CFP; 2212x1659px; 45-degree field of view: 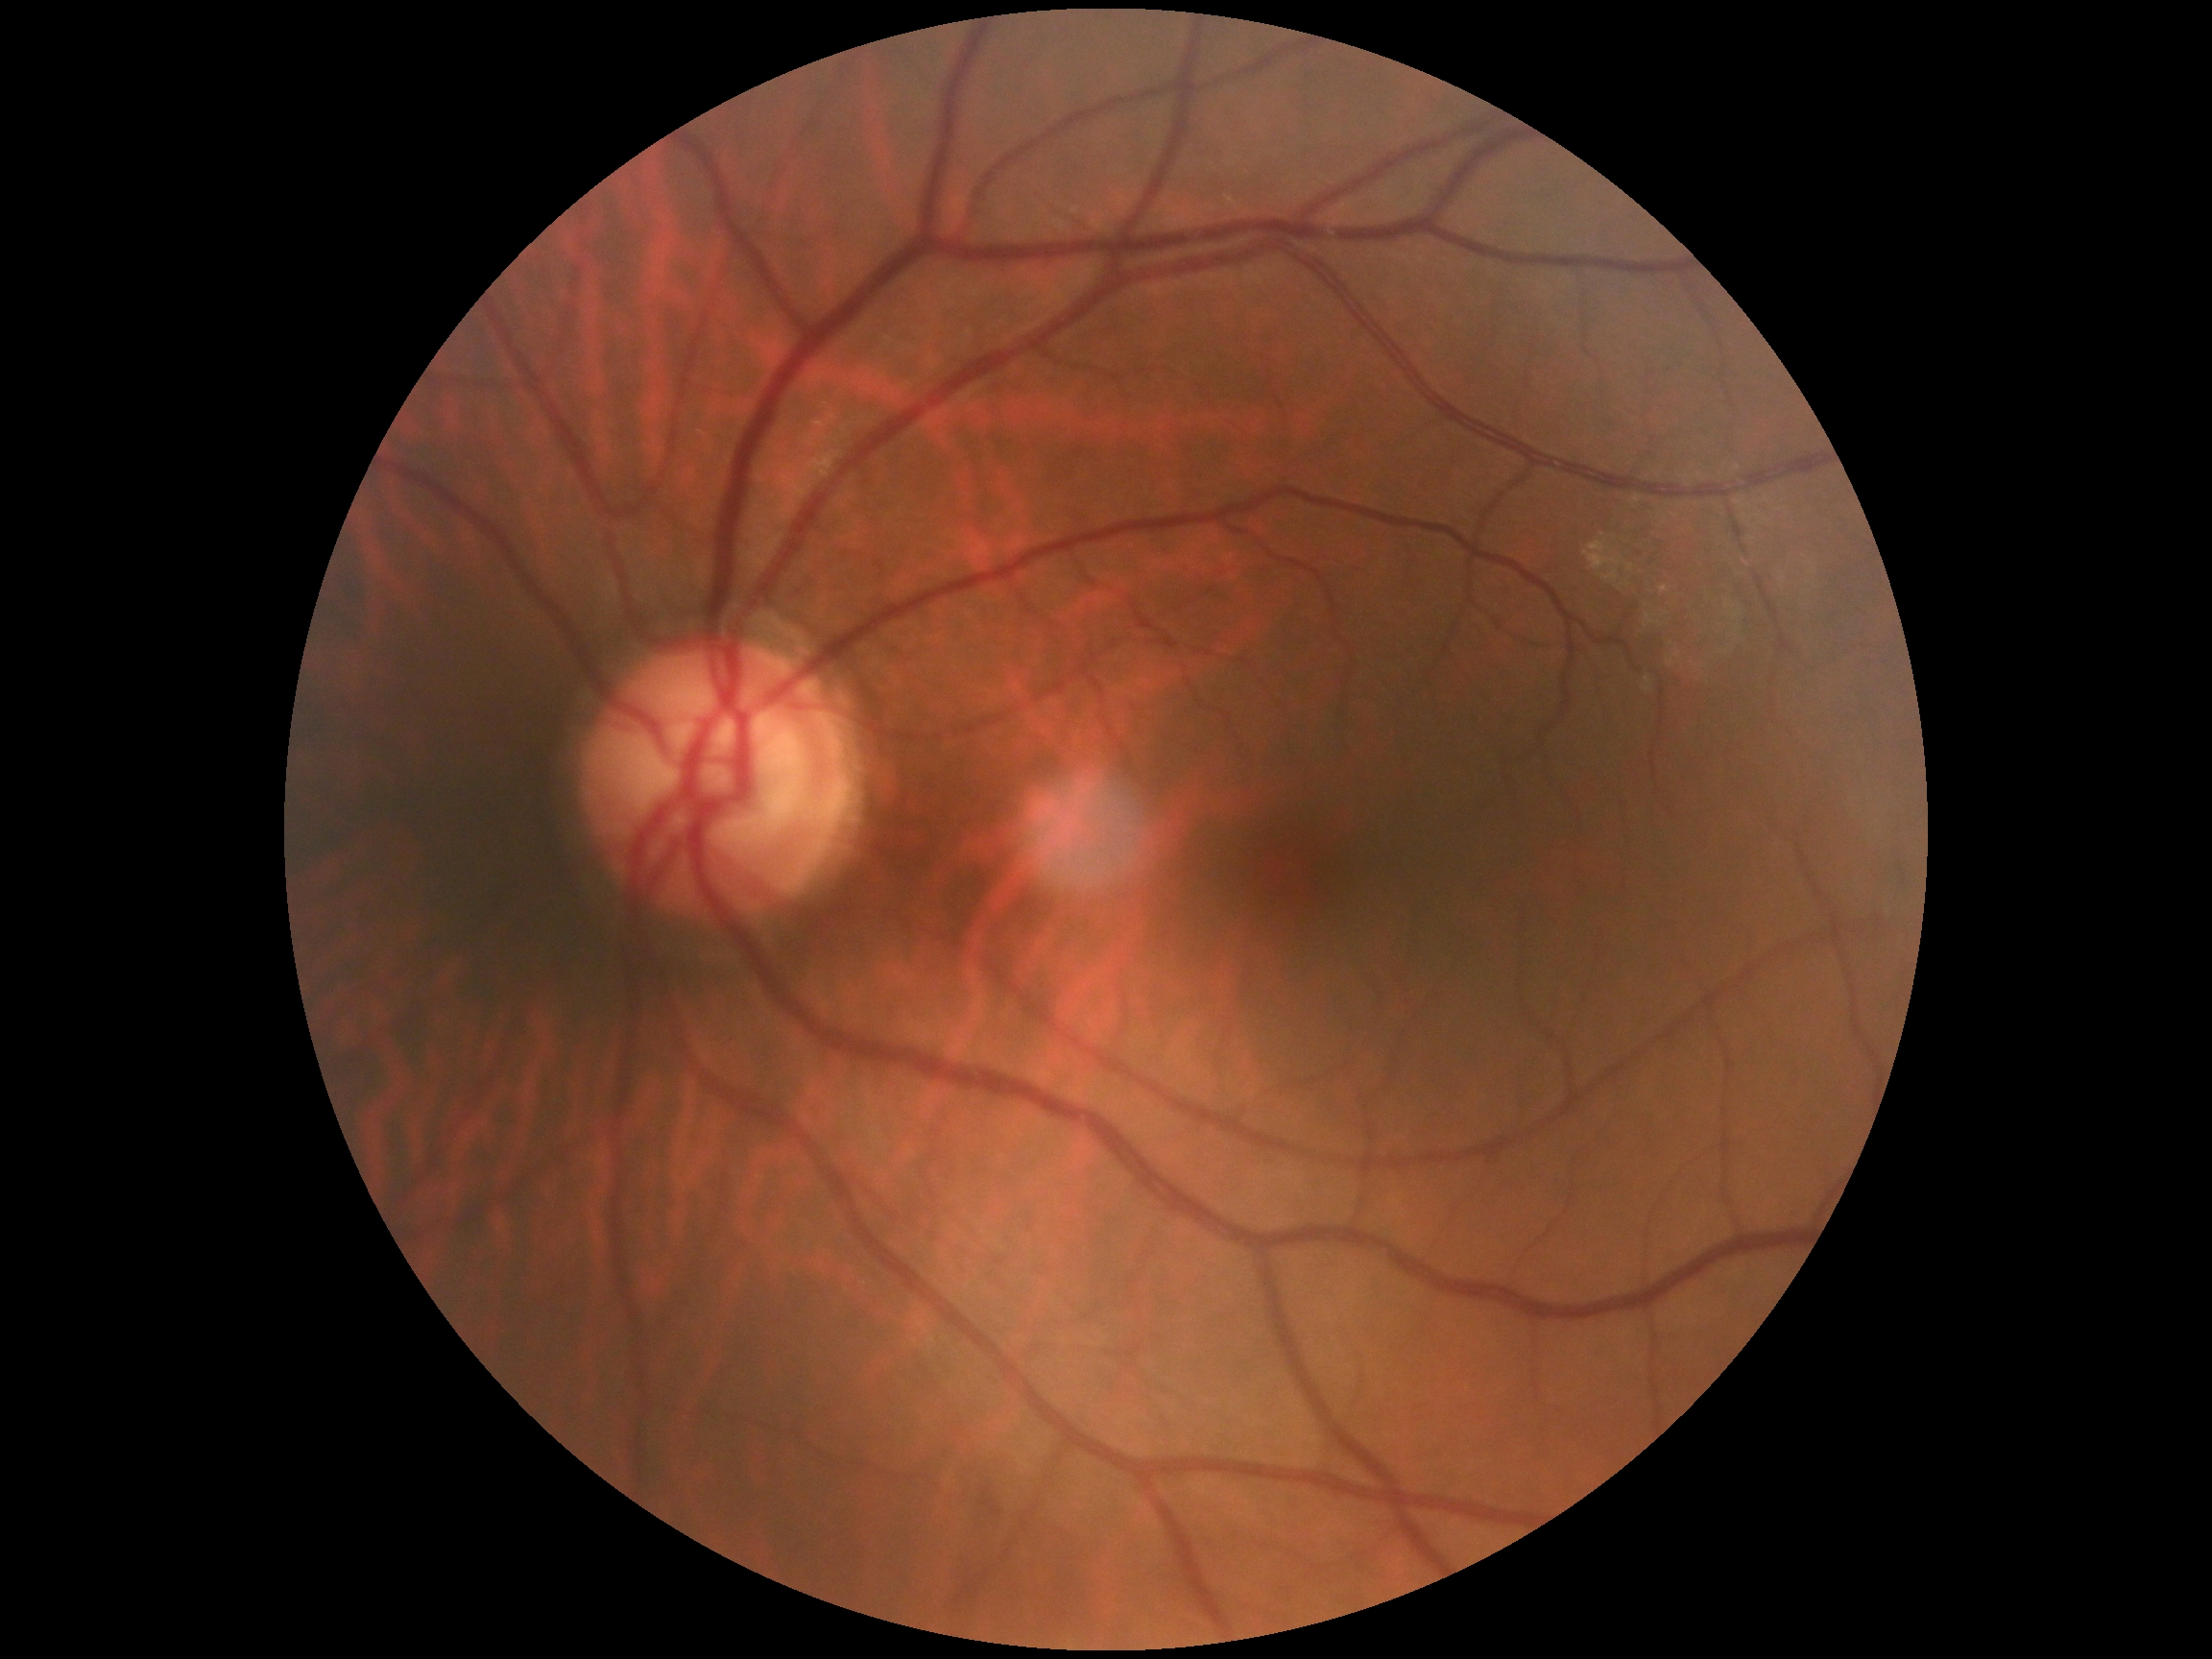

DR stage: 0/4.
No DR findings.